Color fundus image — 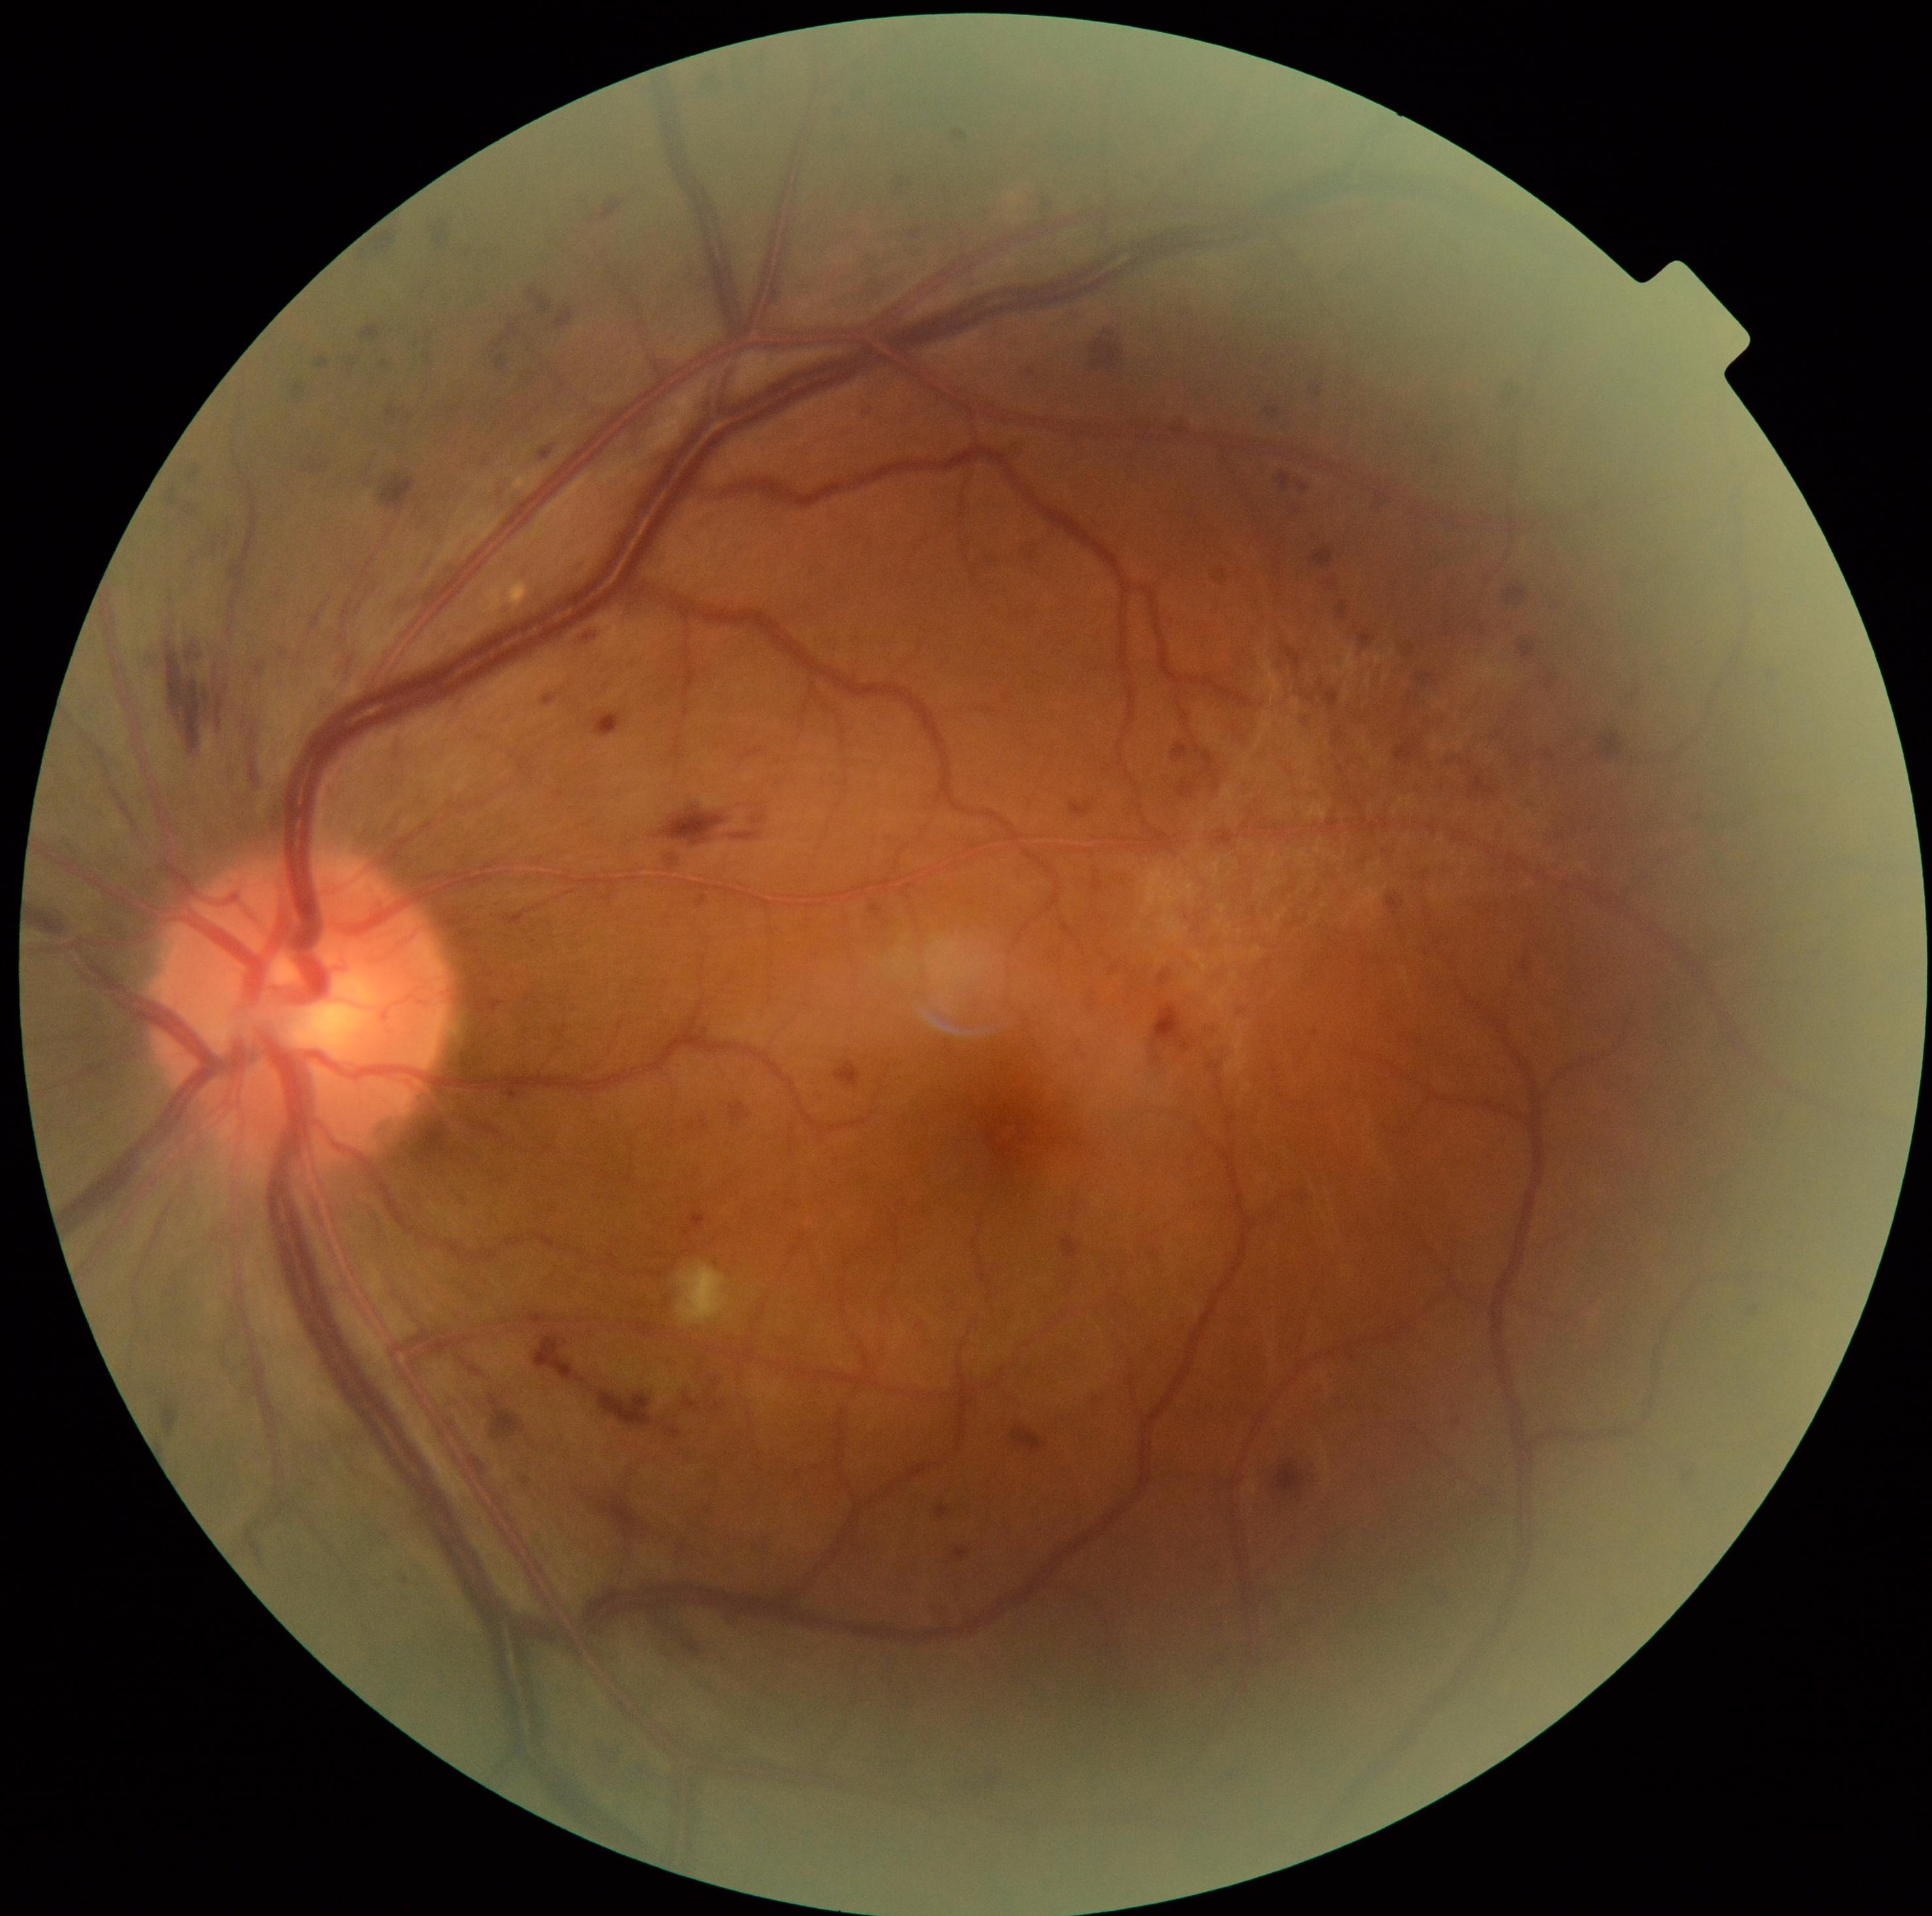 DR: grade 3 — more than 20 intraretinal hemorrhages in each of 4 quadrants, definite venous beading in 2 or more quadrants, or prominent intraretinal microvascular abnormalities in 1 or more quadrants, with no signs of proliferative retinopathy.